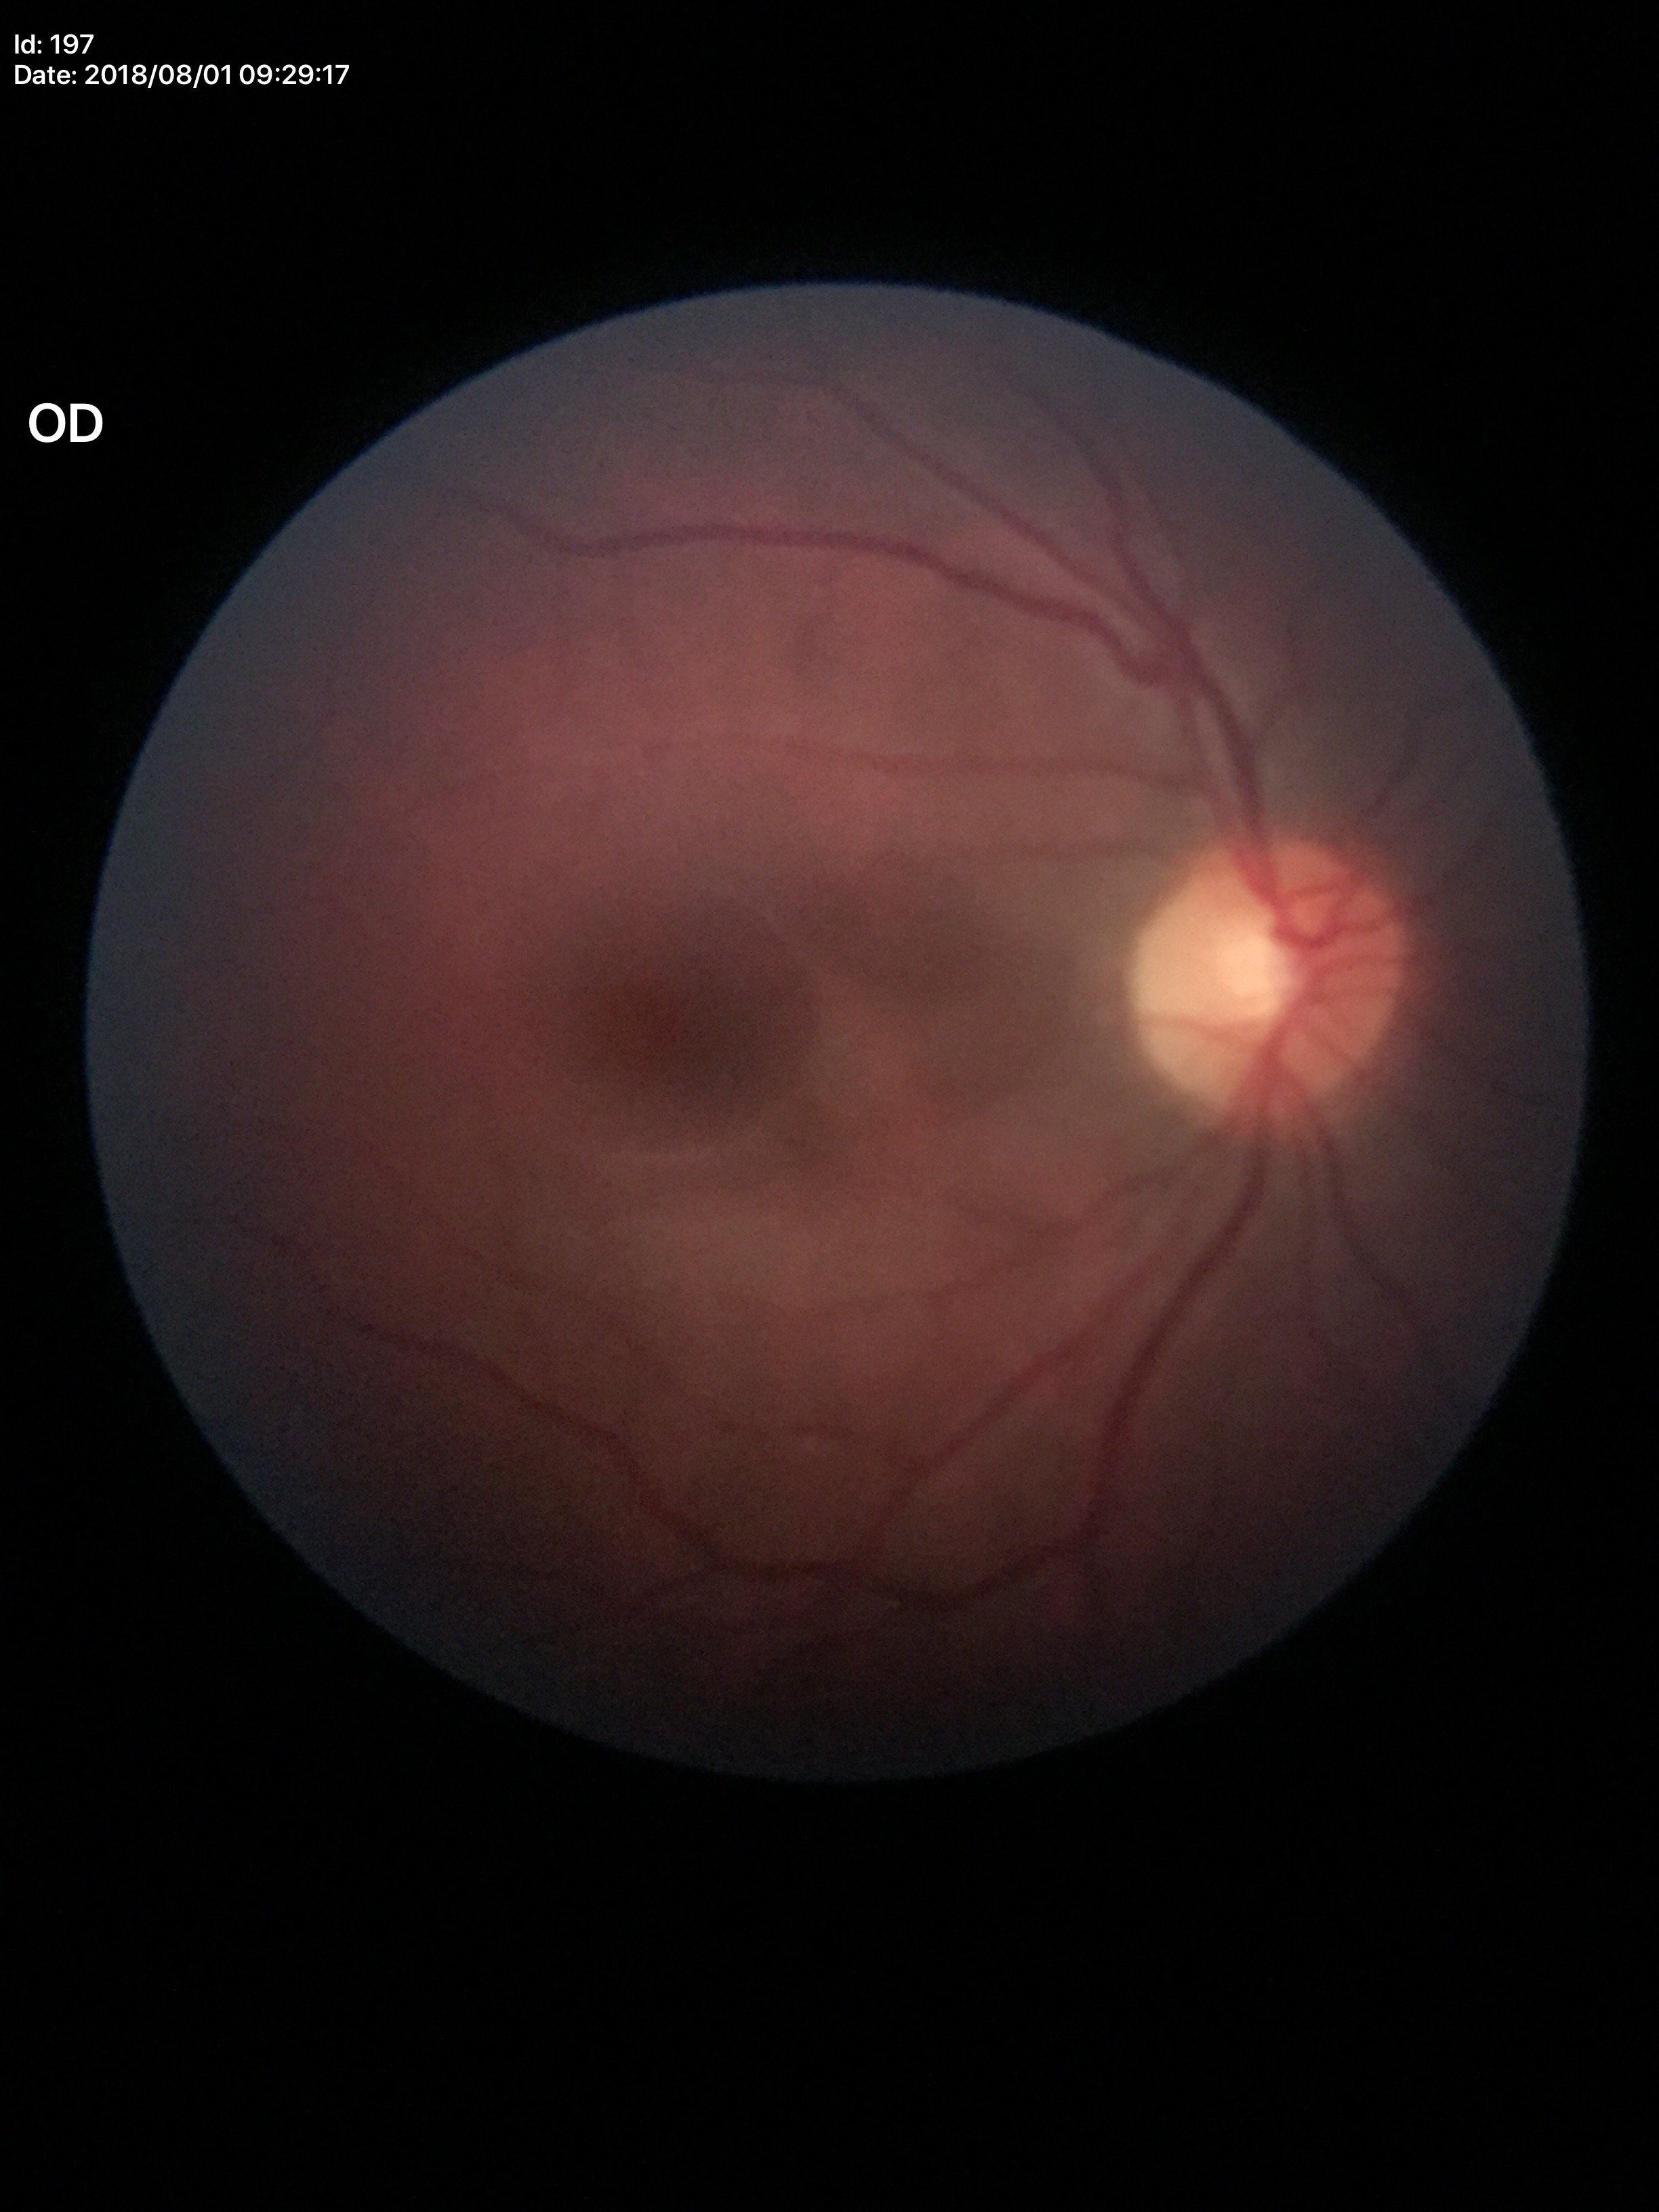
* Glaucoma decision: not suspect (unanimous normal call)
* vertical CDR: 0.47